2352x1568px, 45° FOV
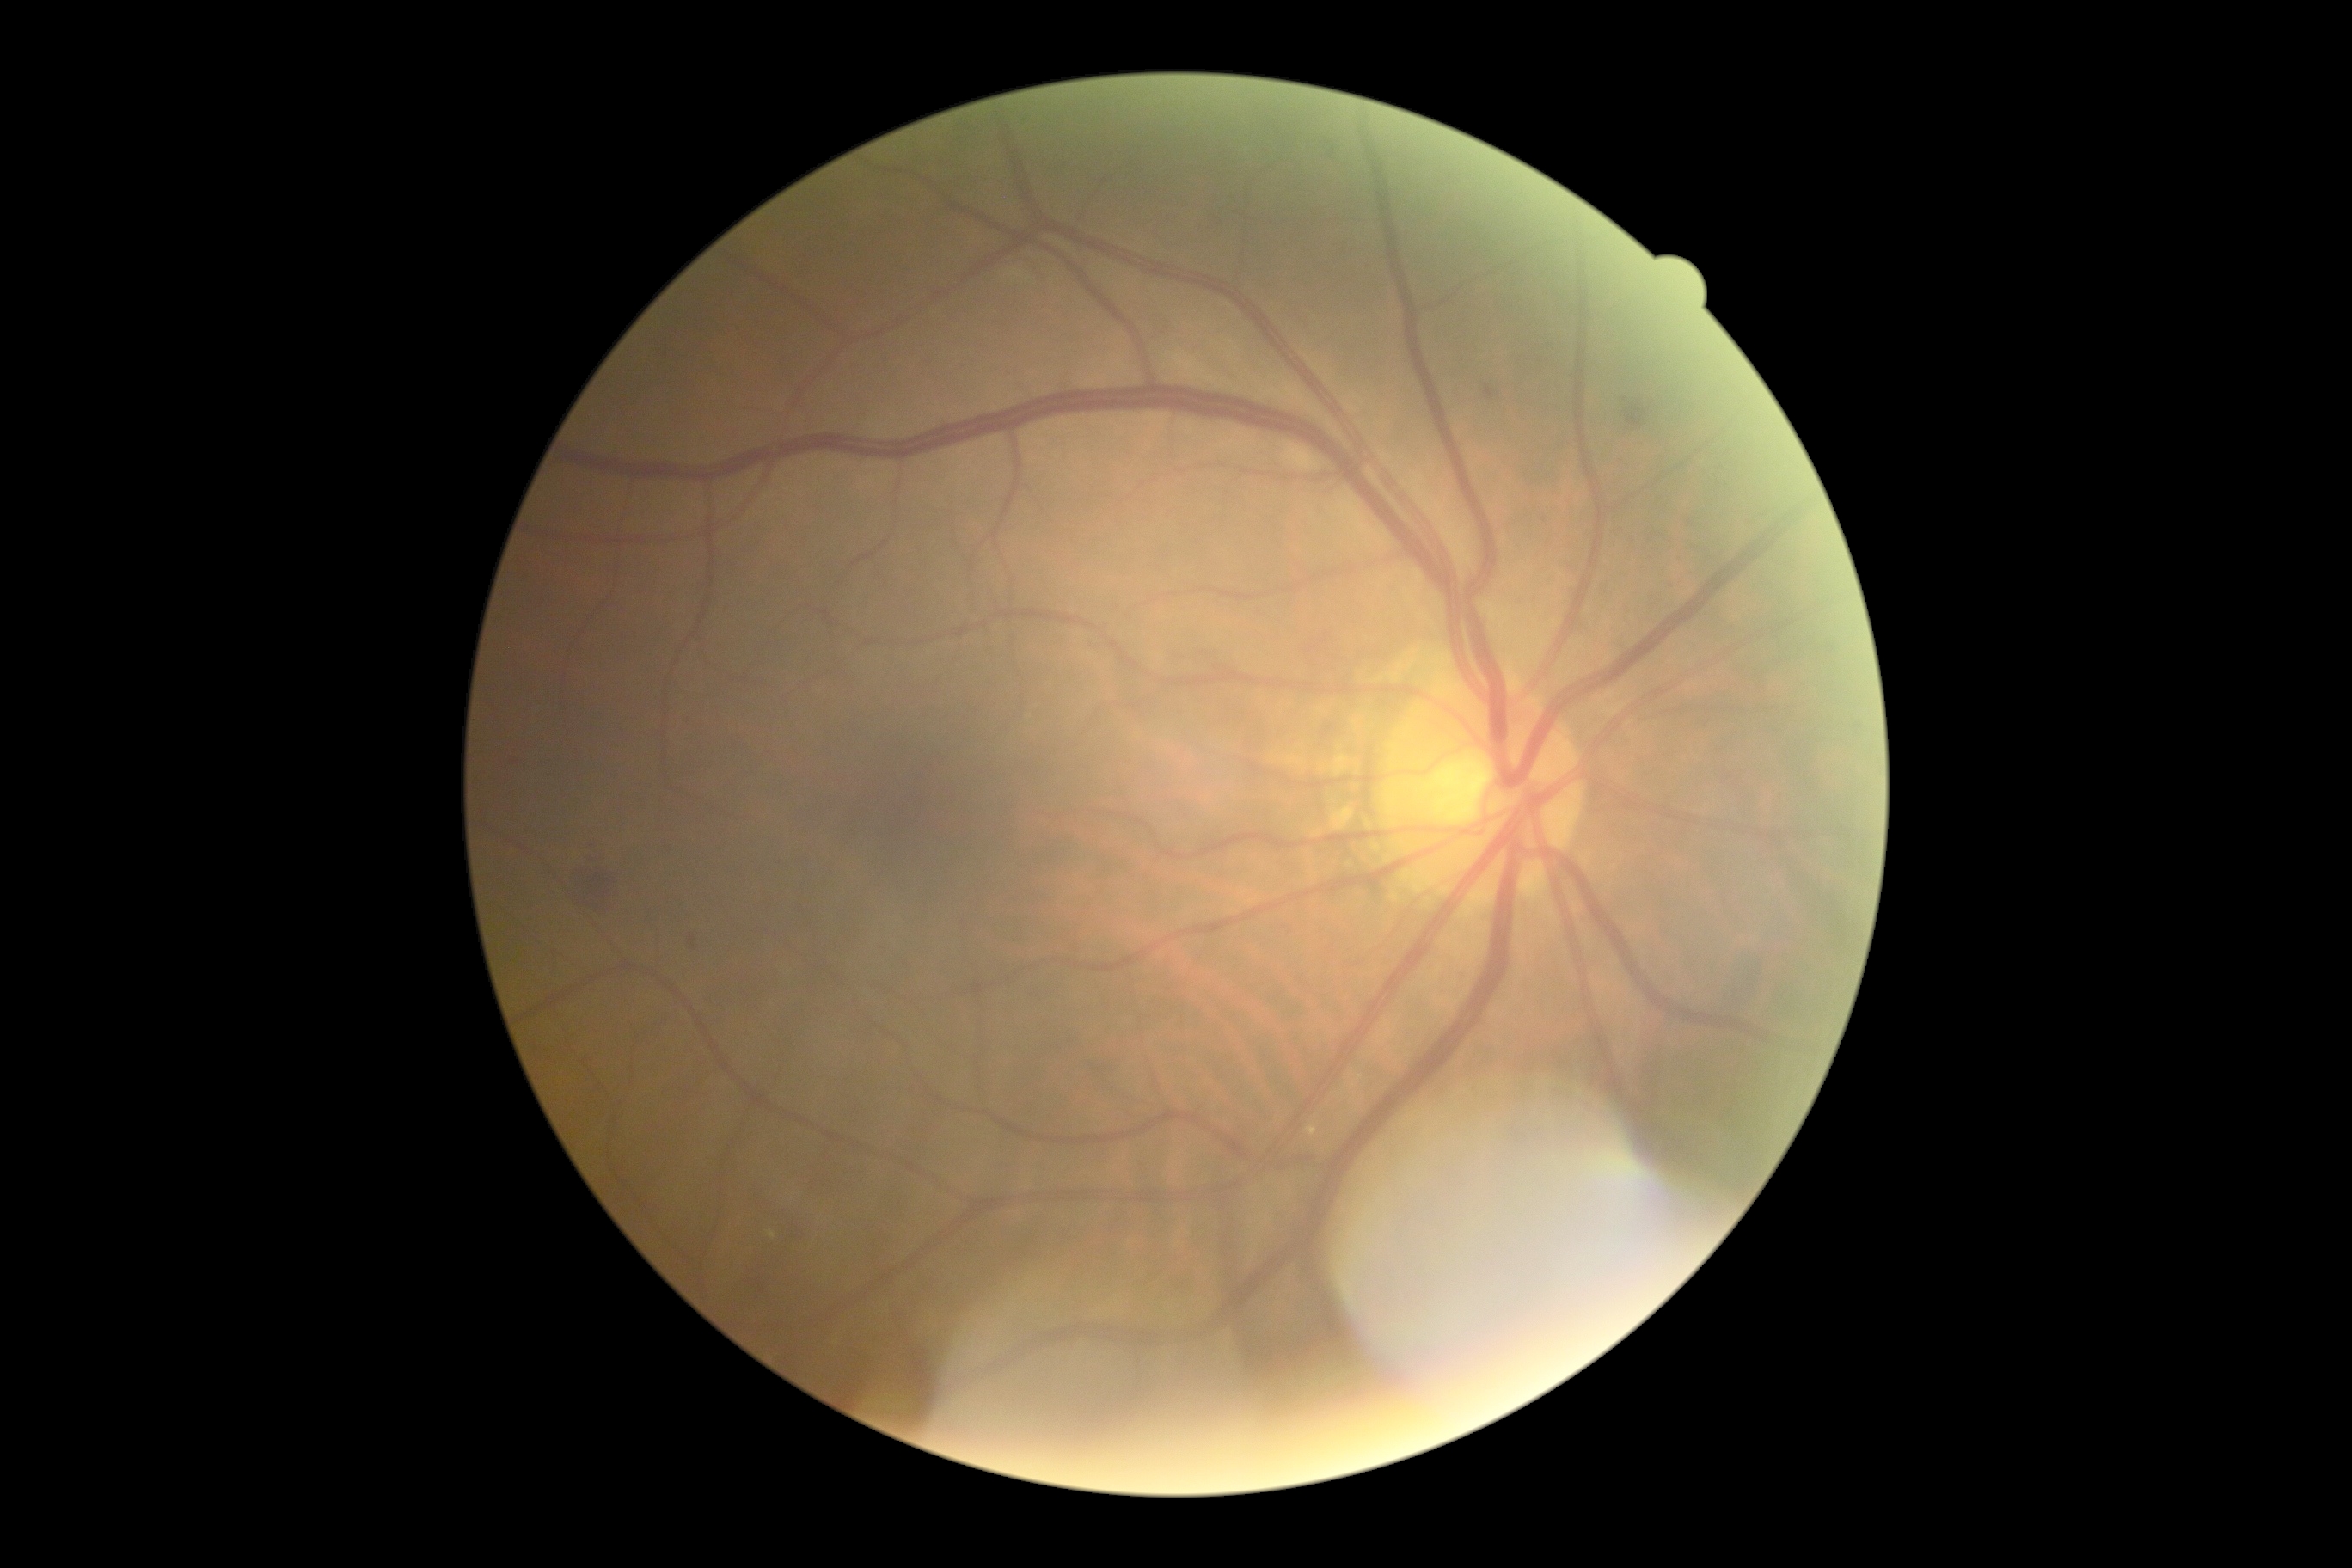
DR stage is grade 2 (moderate NPDR).